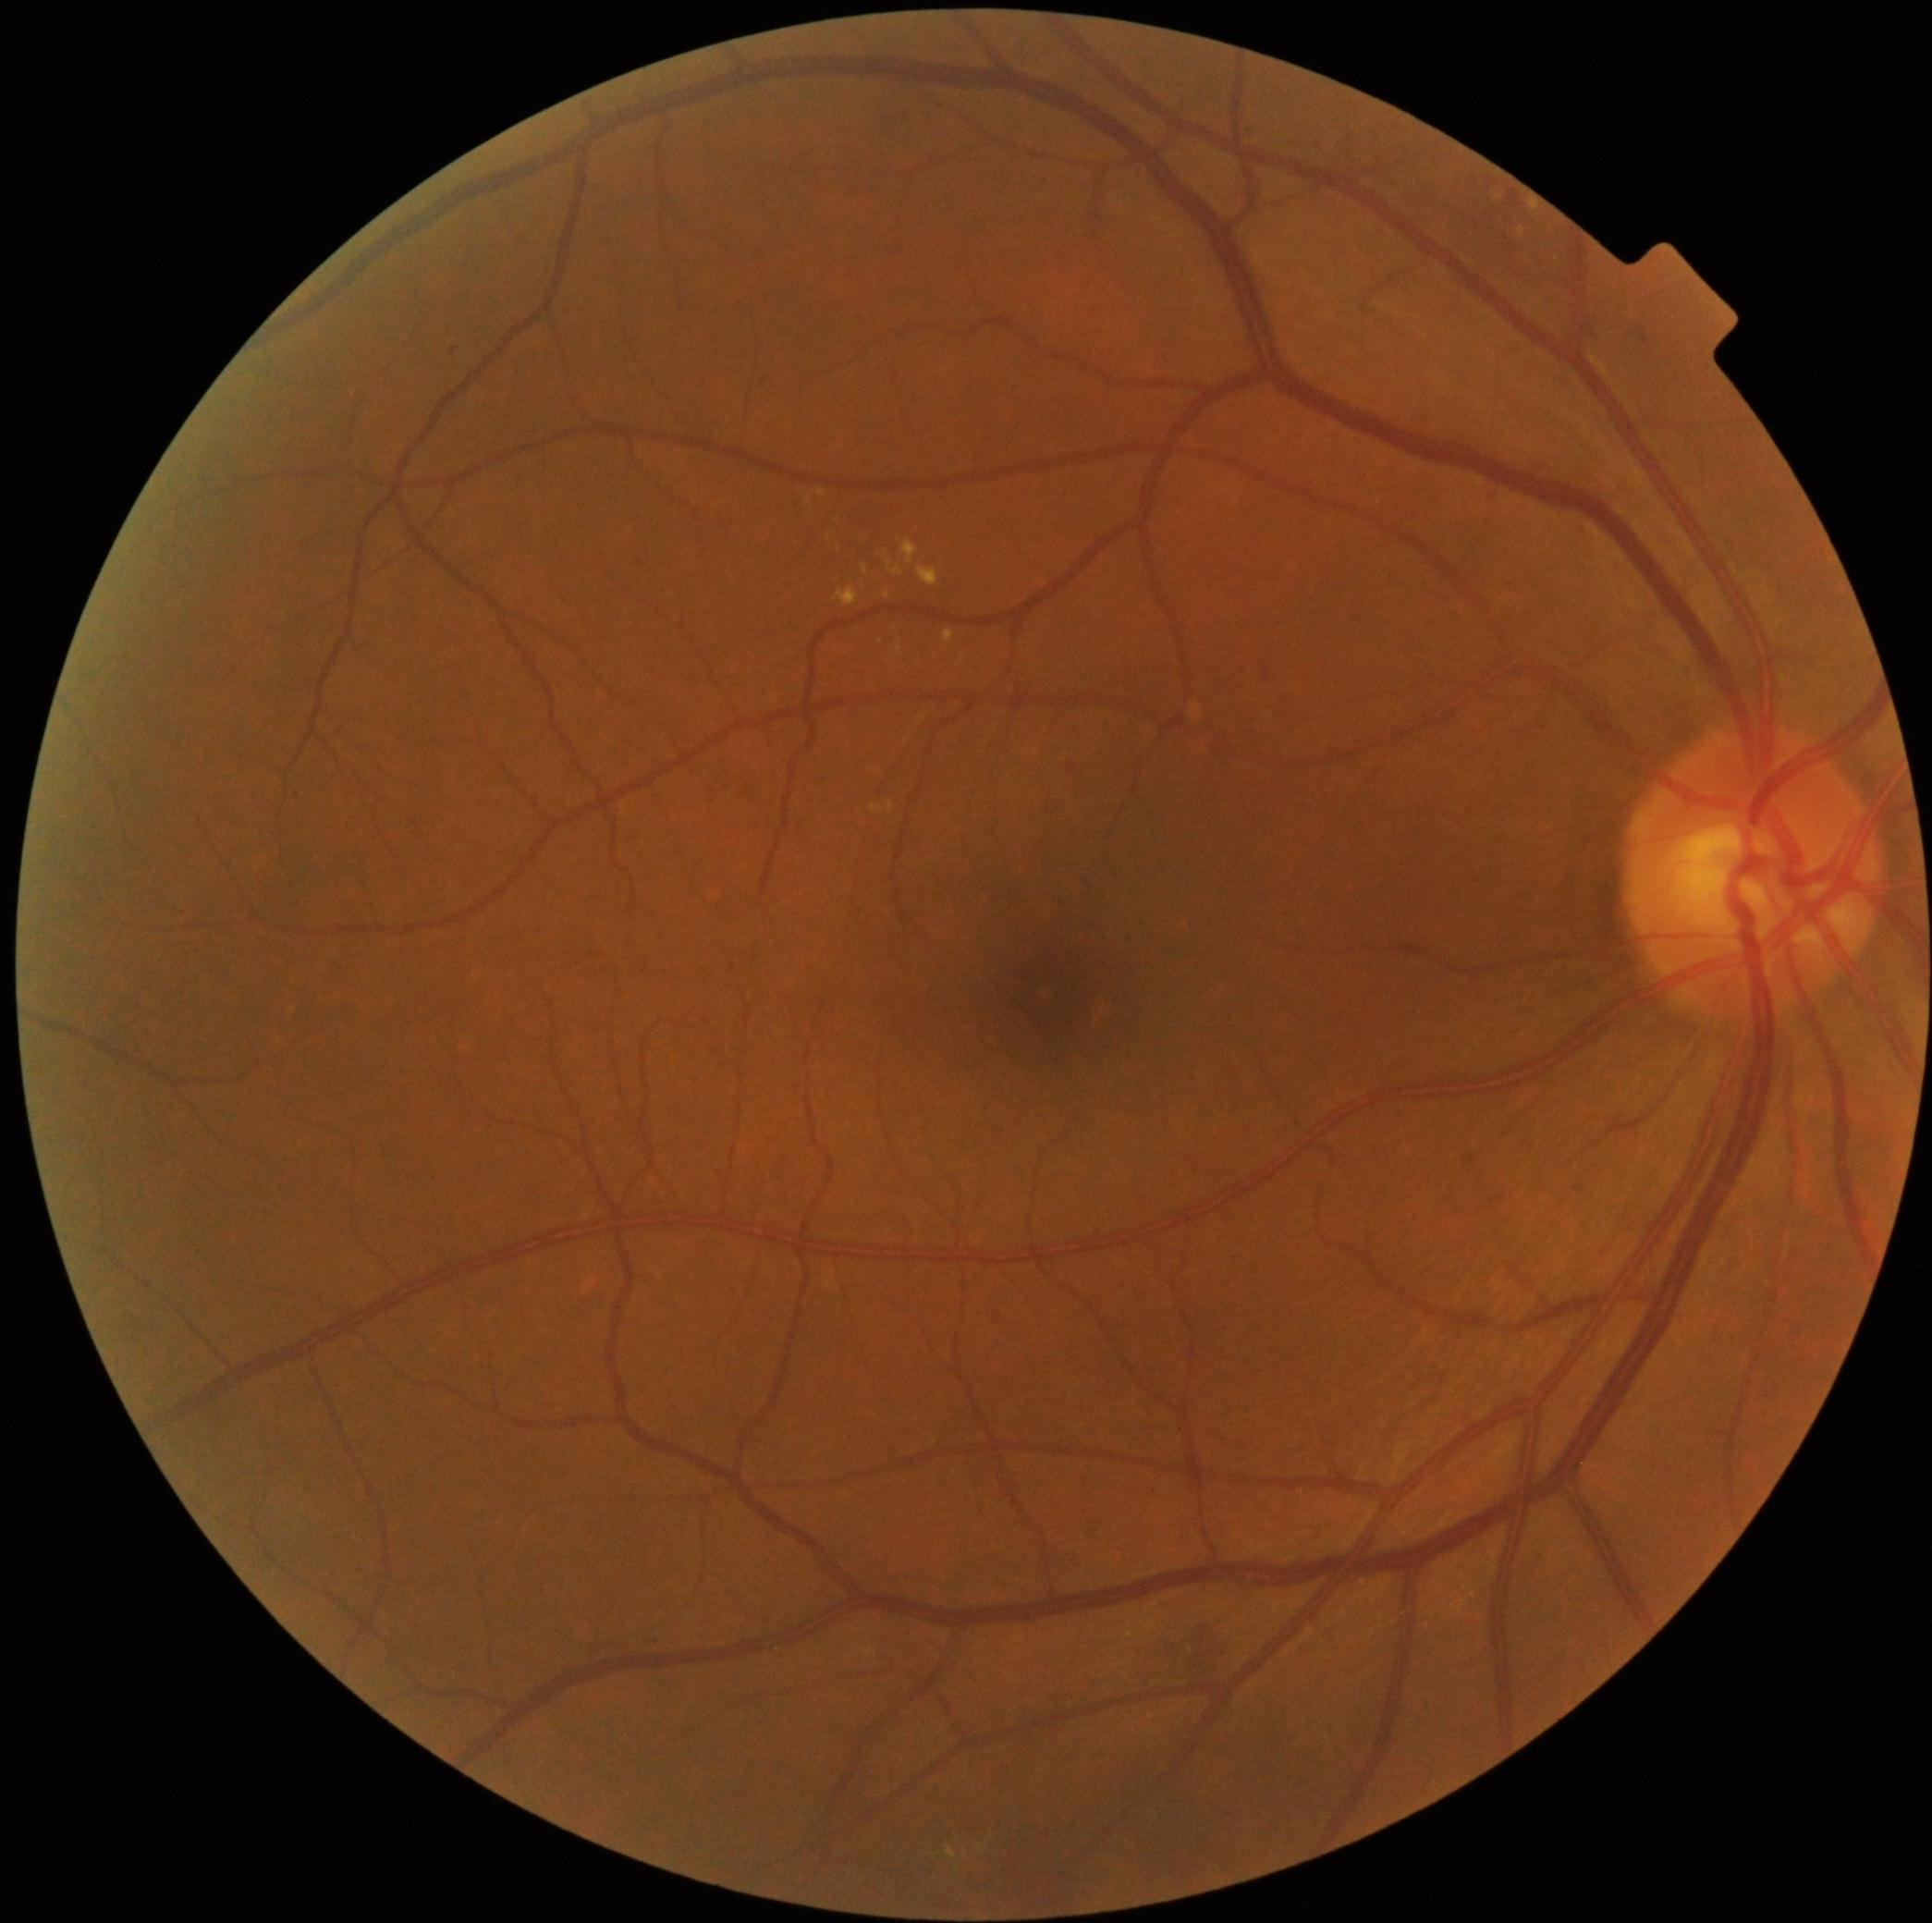
DR class@non-proliferative diabetic retinopathy, DR stage@grade 2 (moderate NPDR) — more than just microaneurysms but less than severe NPDR.